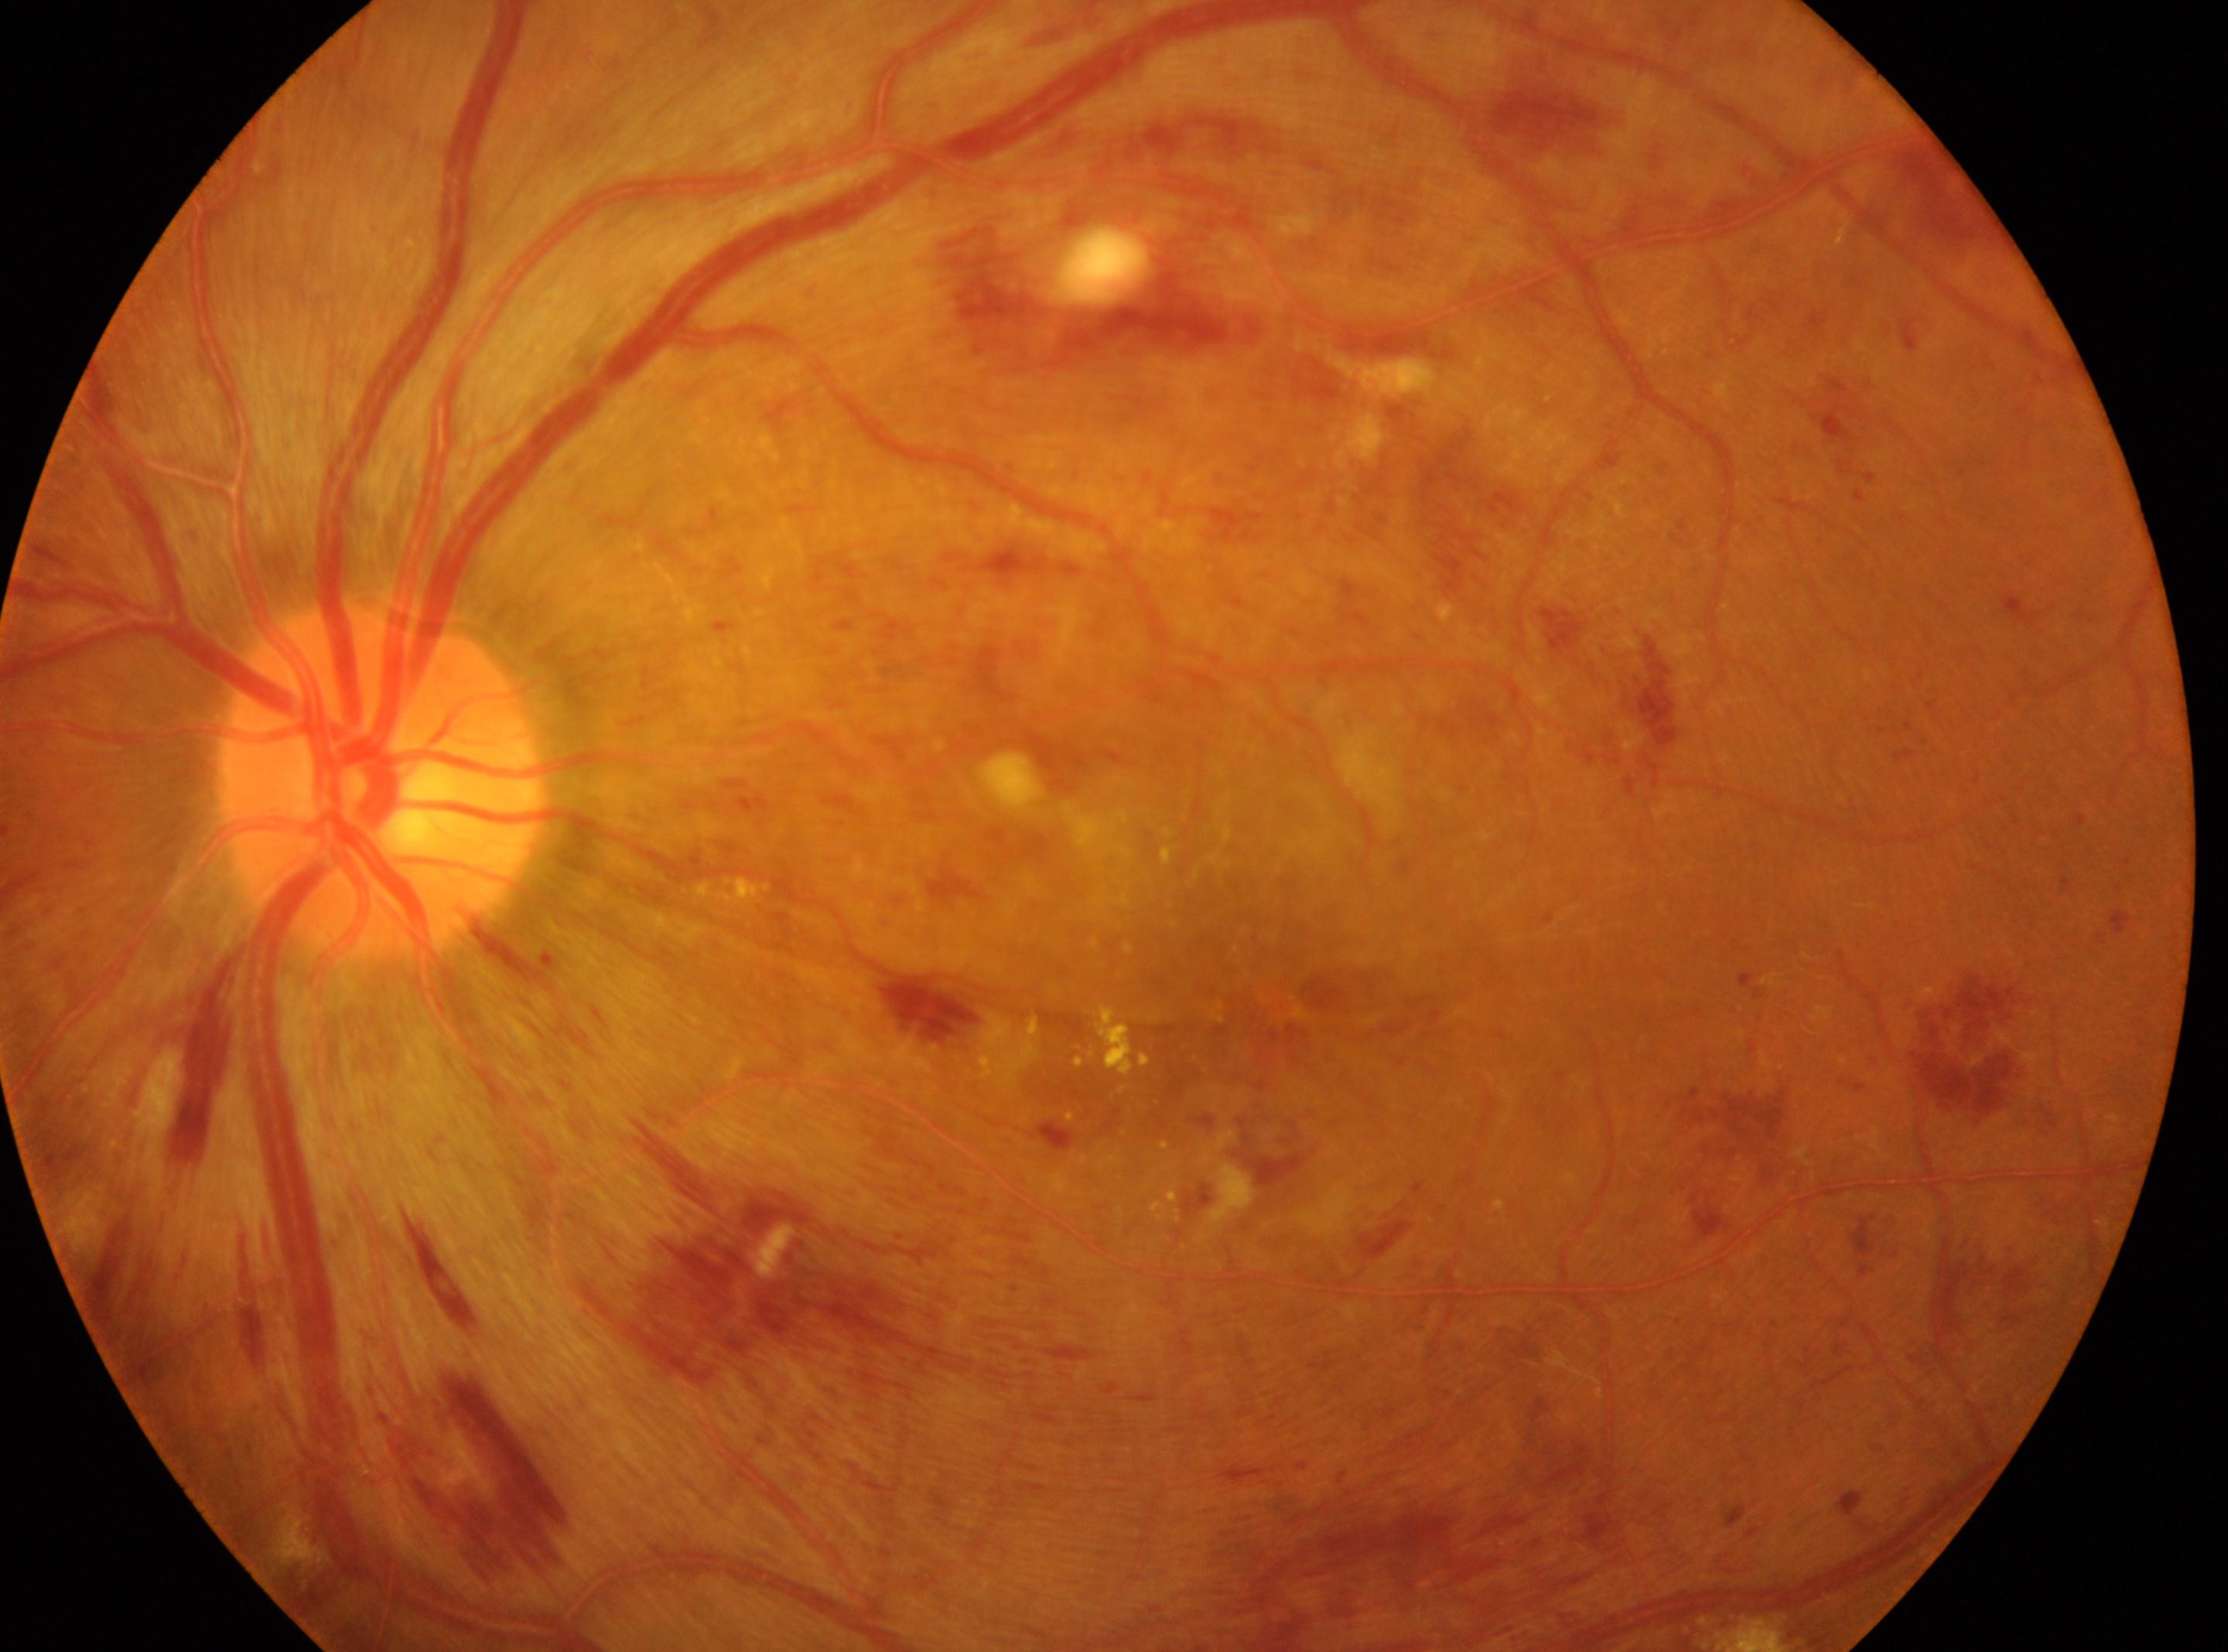 This is the left eye.
DR stage is grade 3.
Optic disc located at 381px, 777px.
The macular center is at 1281px, 1004px.